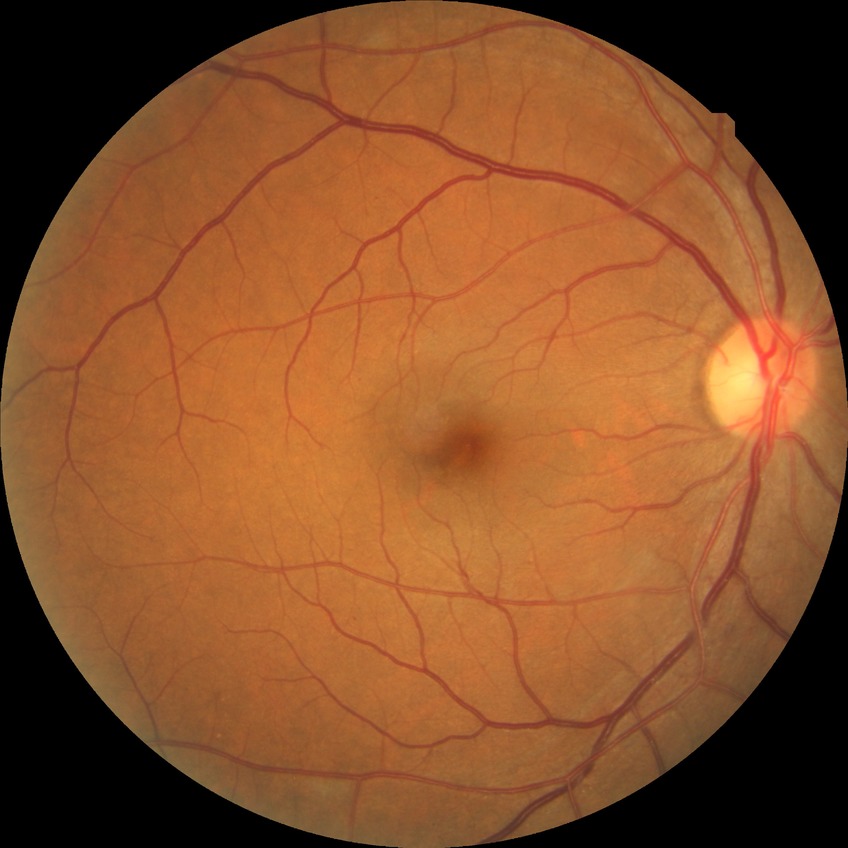

Disease class: non-proliferative diabetic retinopathy. Retinopathy stage: simple diabetic retinopathy.